130° field of view (Clarity RetCam 3); infant wide-field fundus photograph; image size 640x480 — 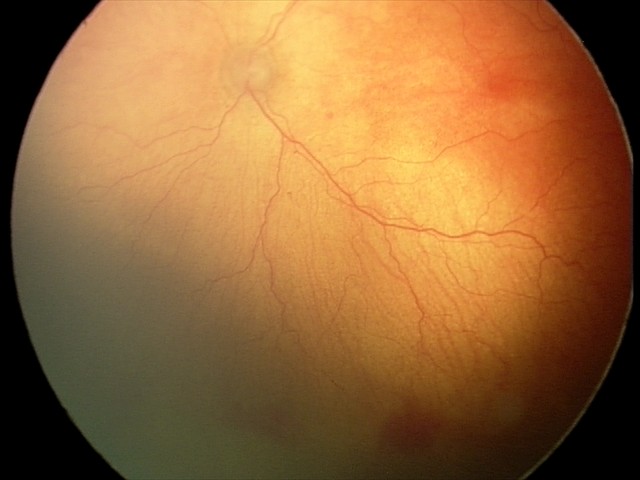
Assessment: aggressive retinopathy of prematurity